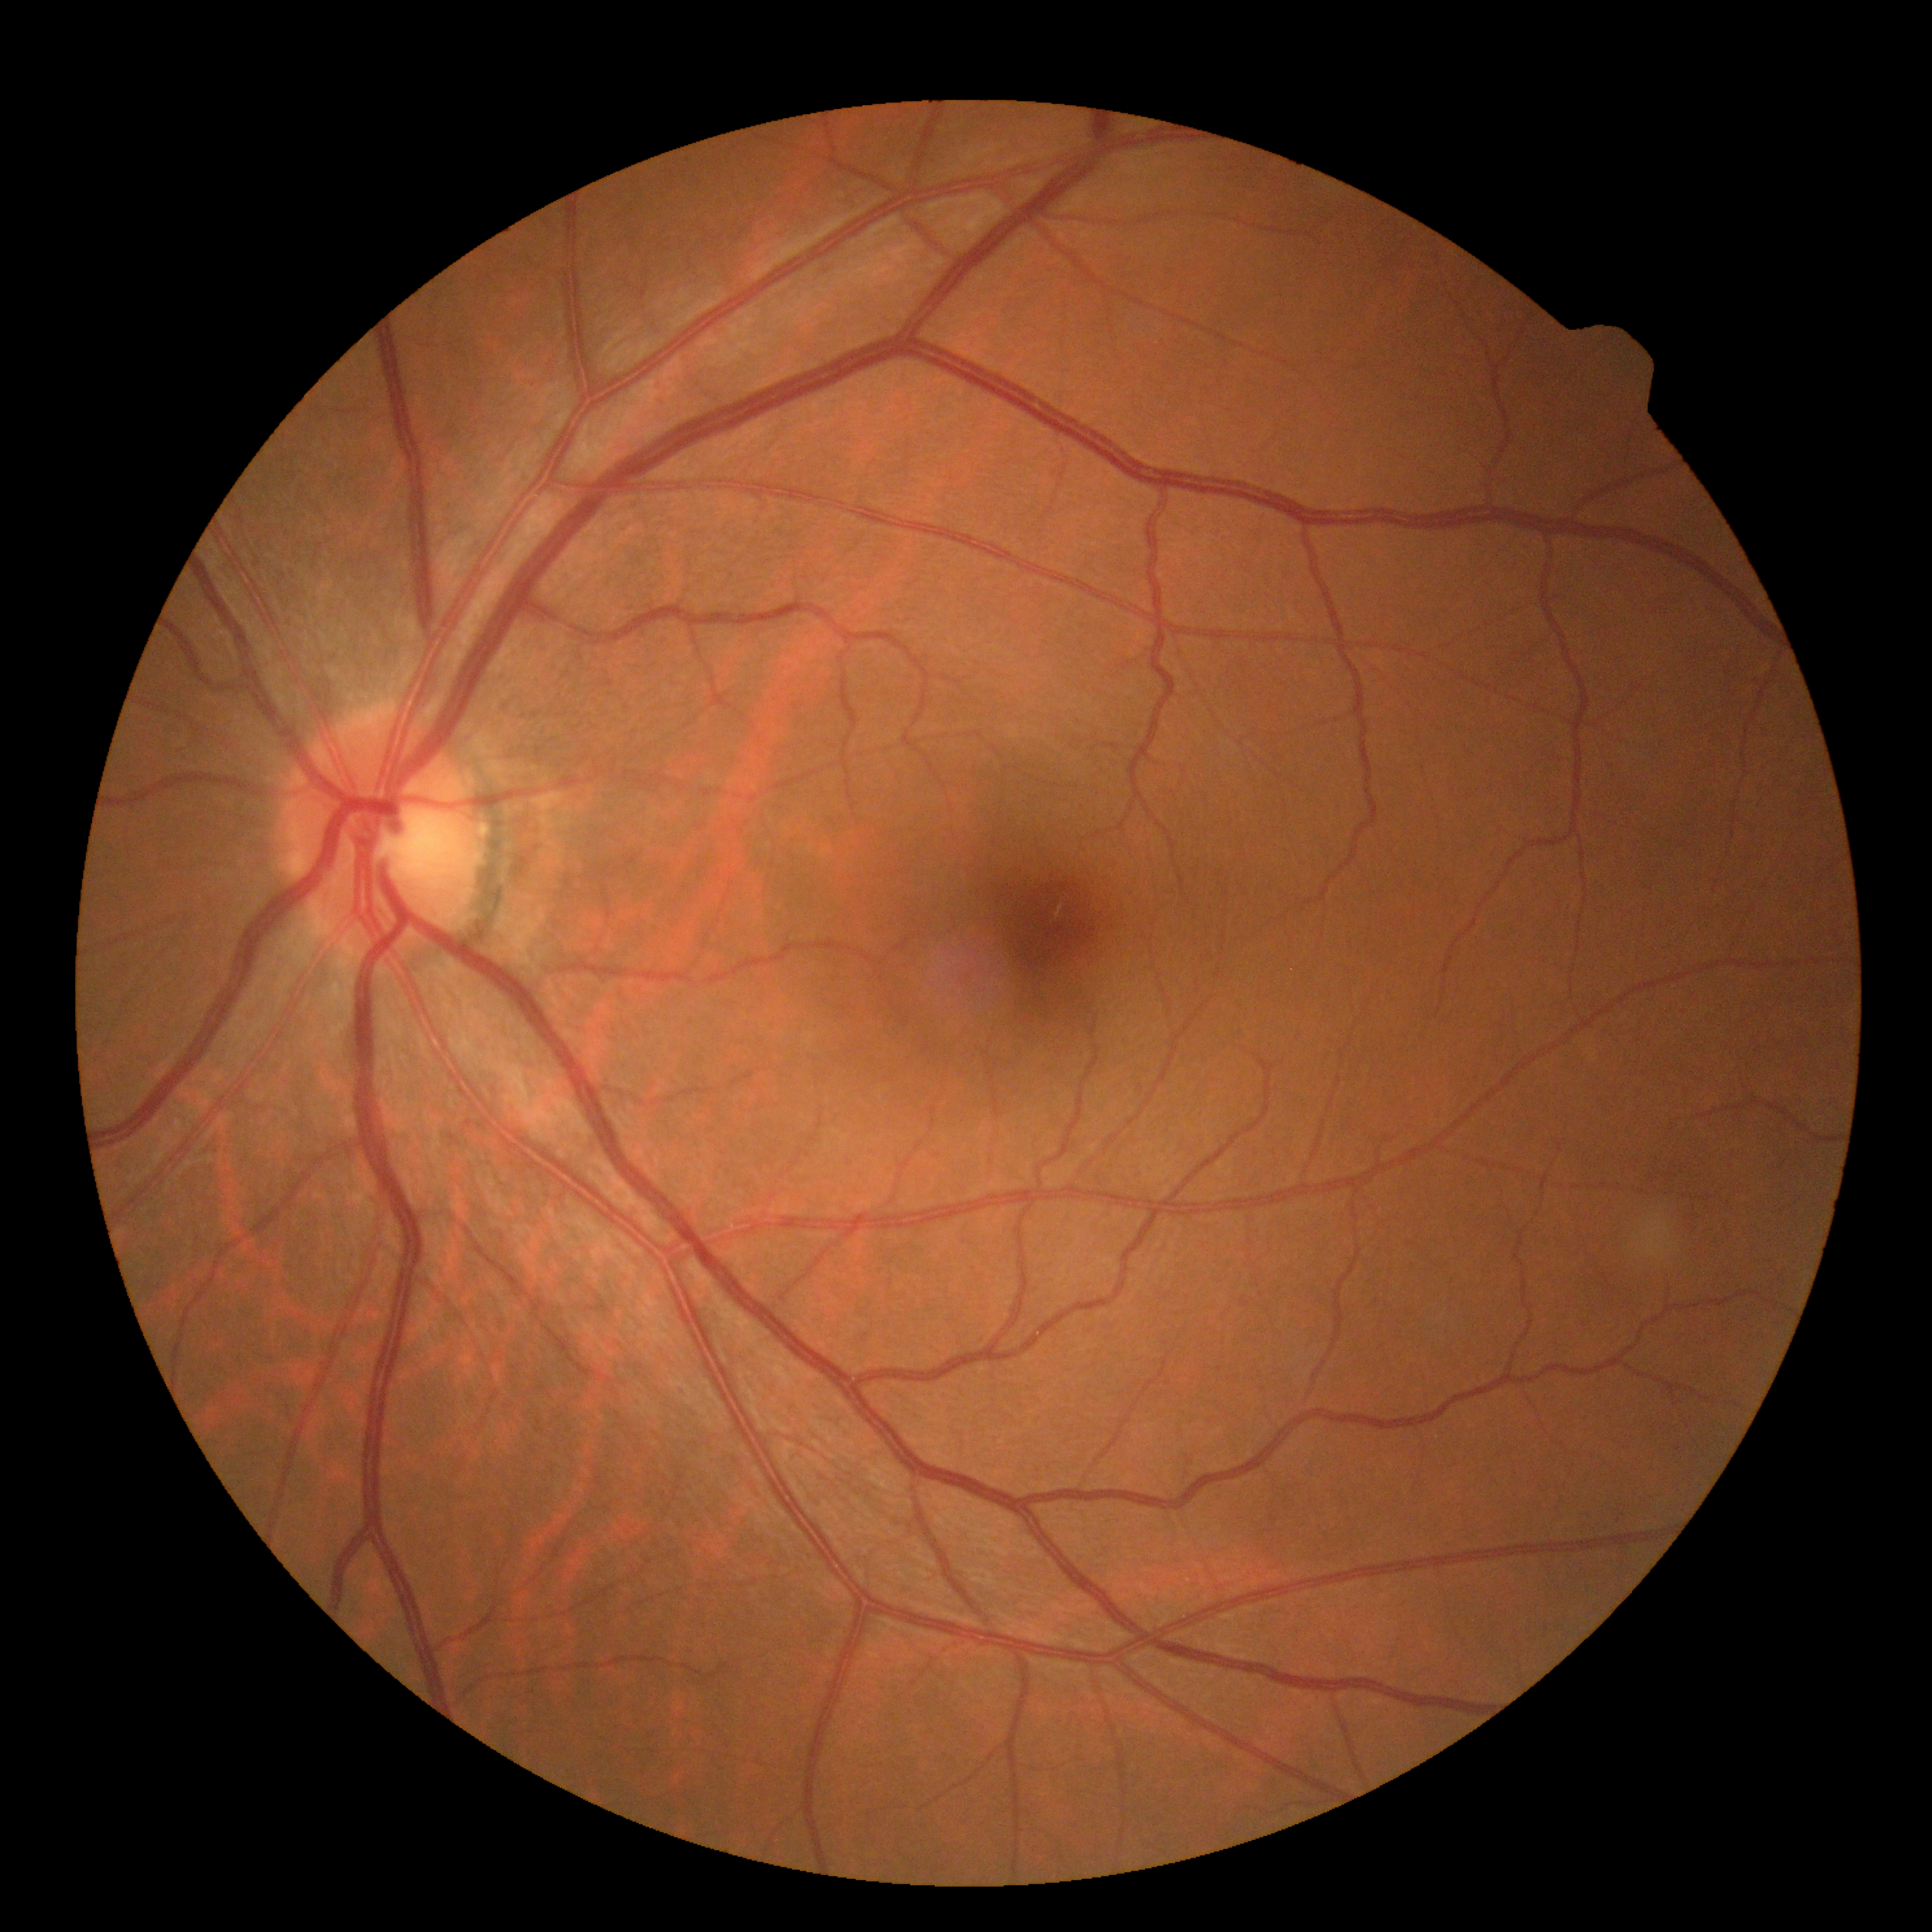 DR stage: grade 0 (no apparent retinopathy) — no visible signs of diabetic retinopathy. No DR findings.